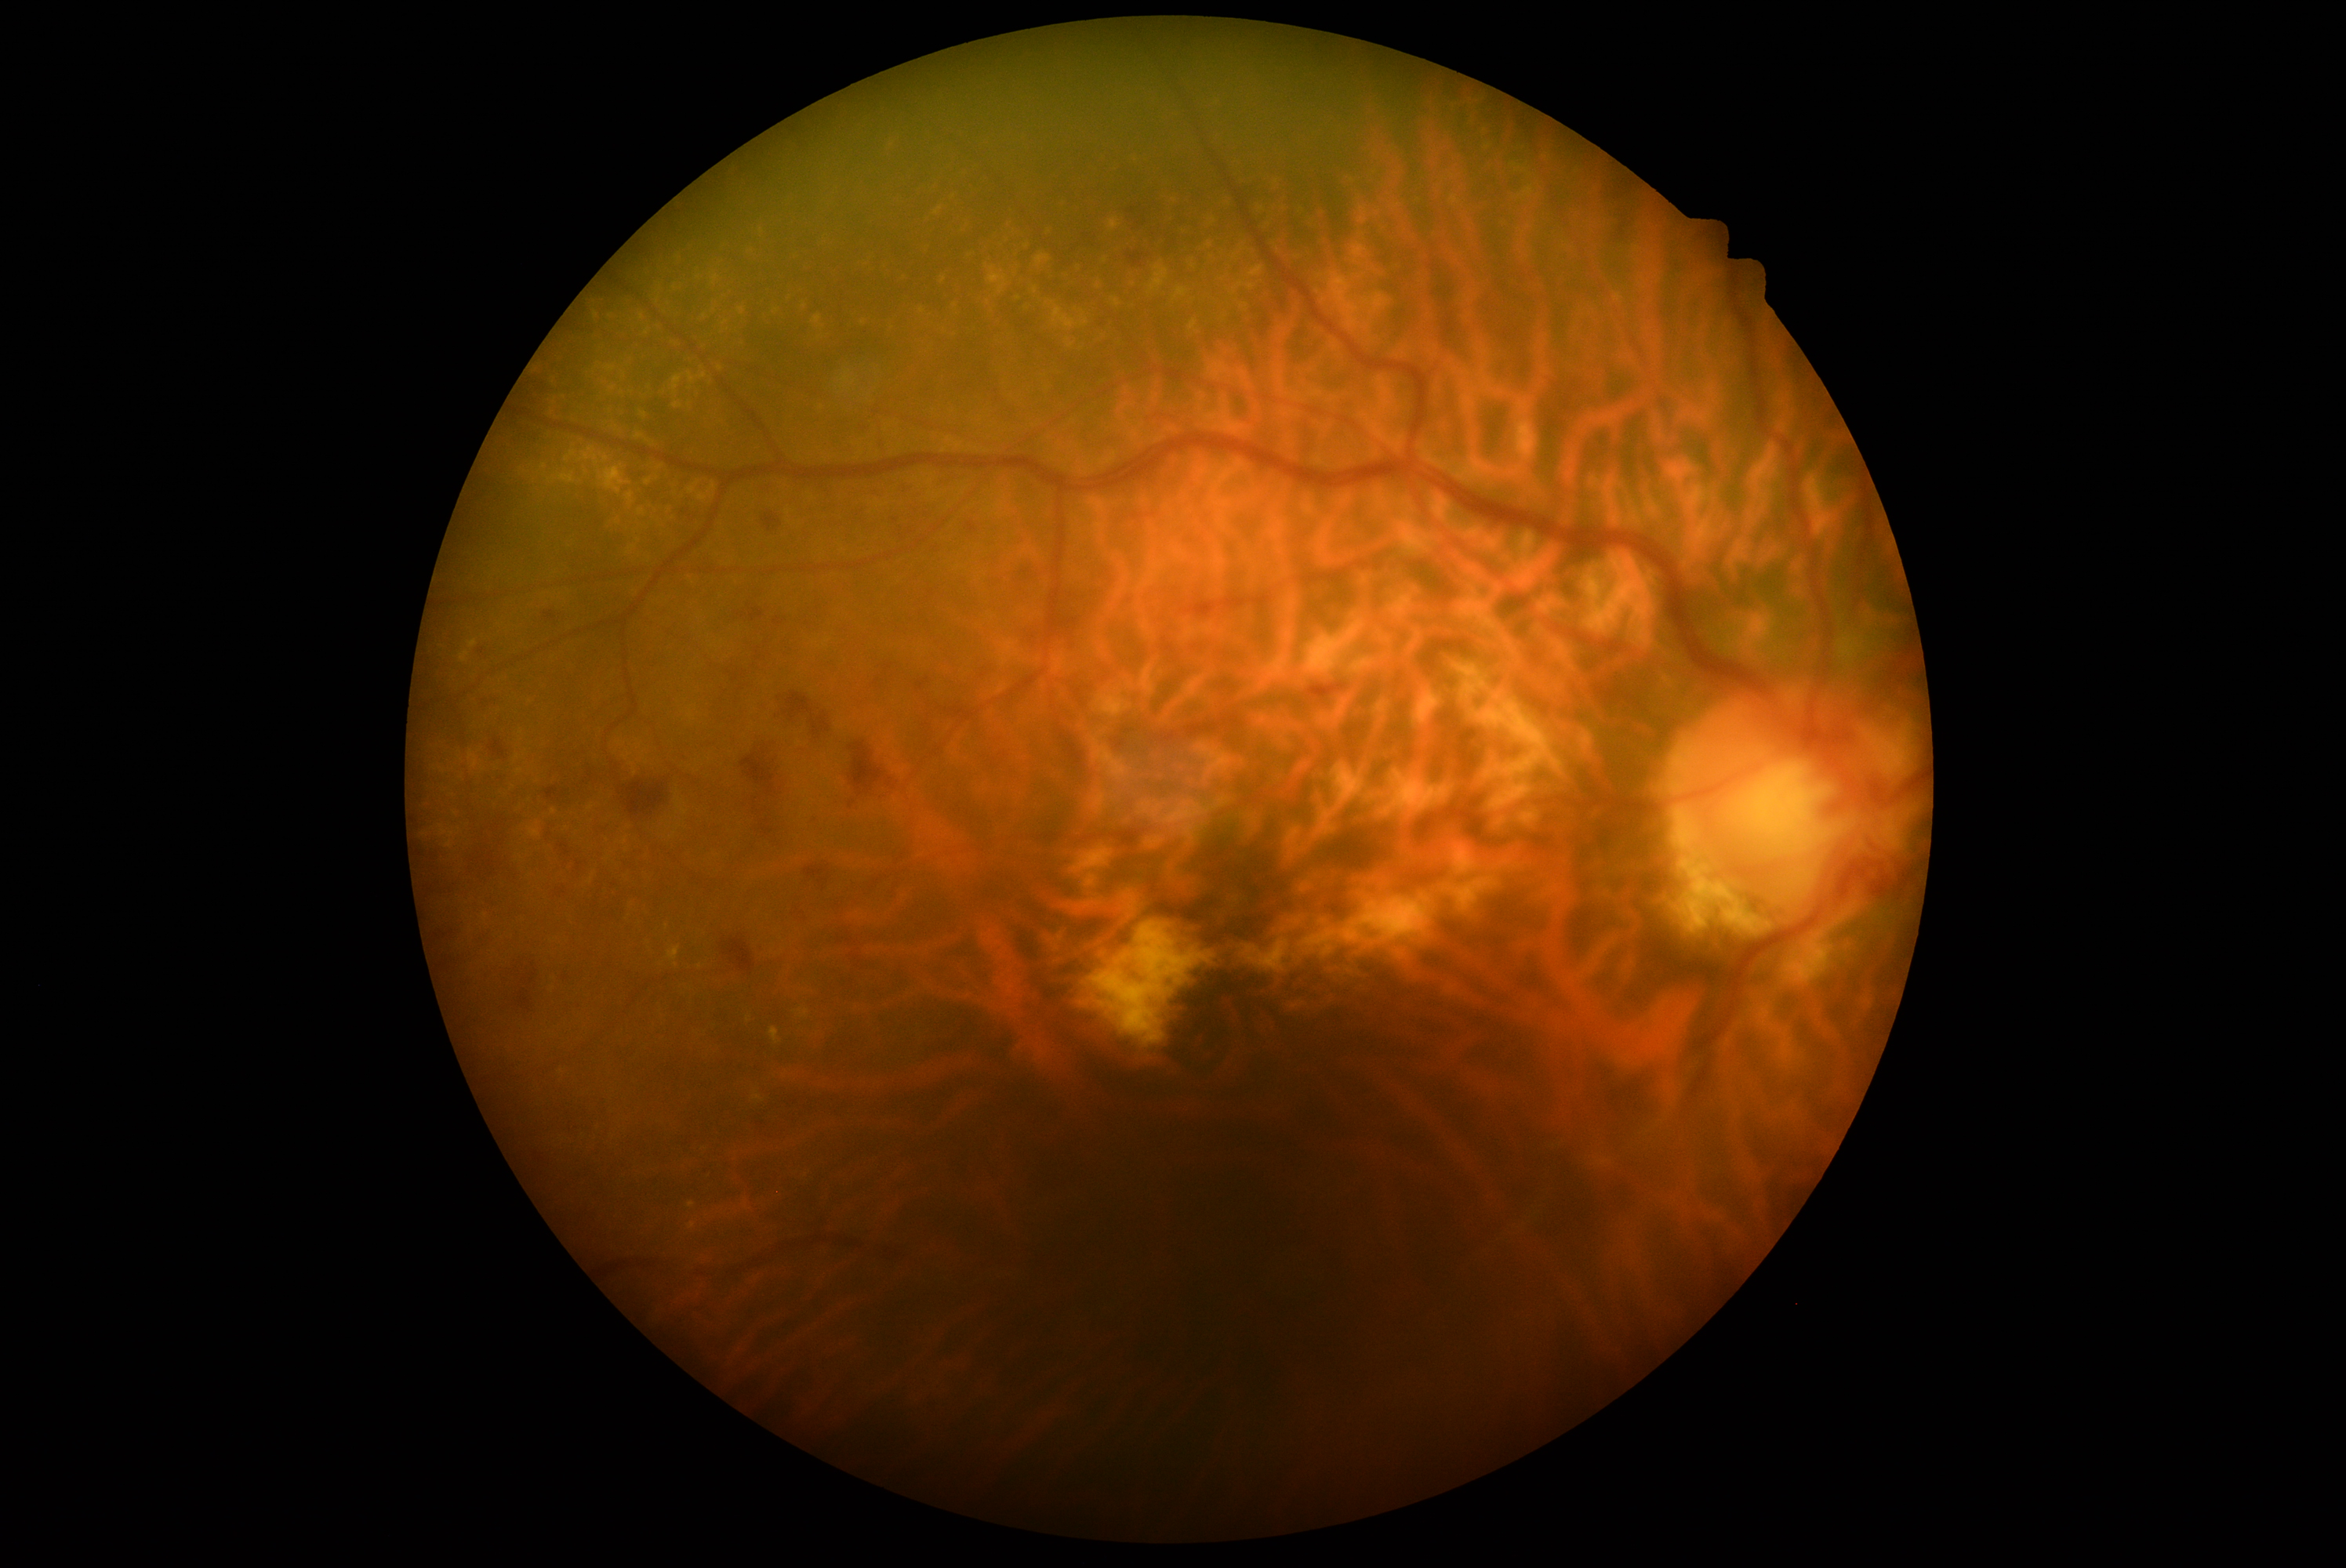

The retinopathy is classified as non-proliferative diabetic retinopathy.
Diabetic retinopathy severity is 2/4 — more than just microaneurysms but less than severe NPDR.